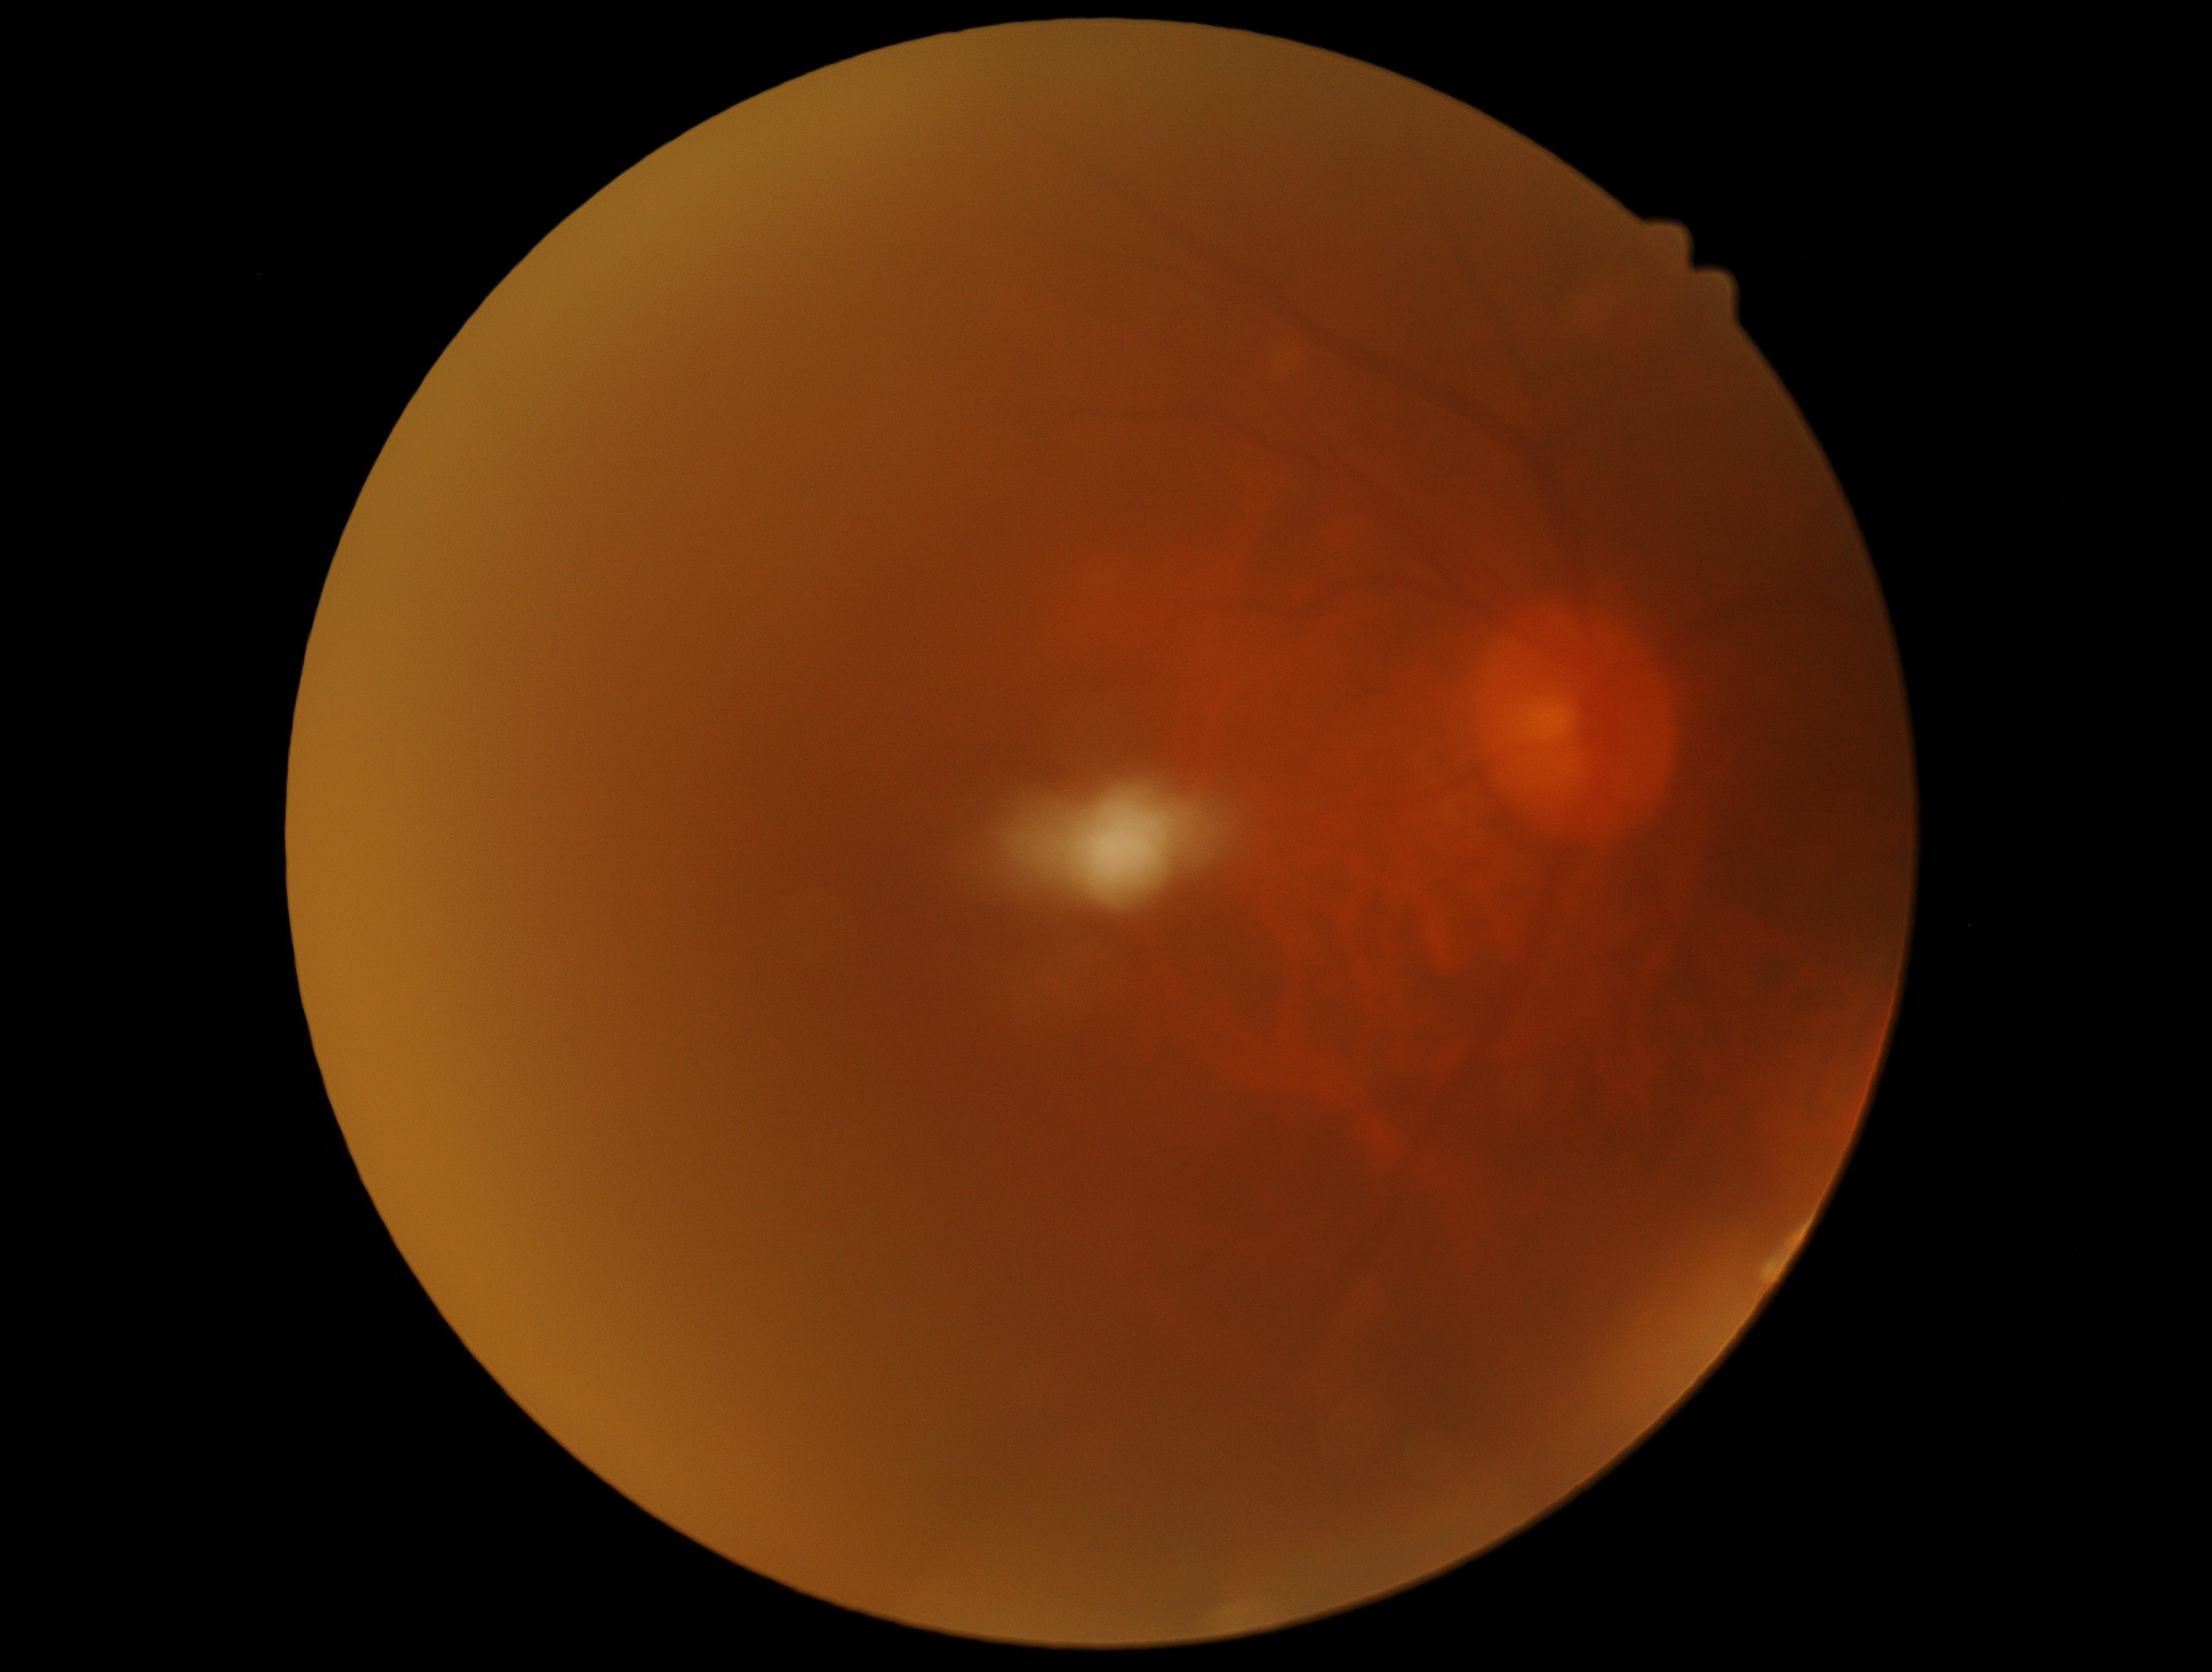

DR grade is 0/4.